Color fundus photograph — 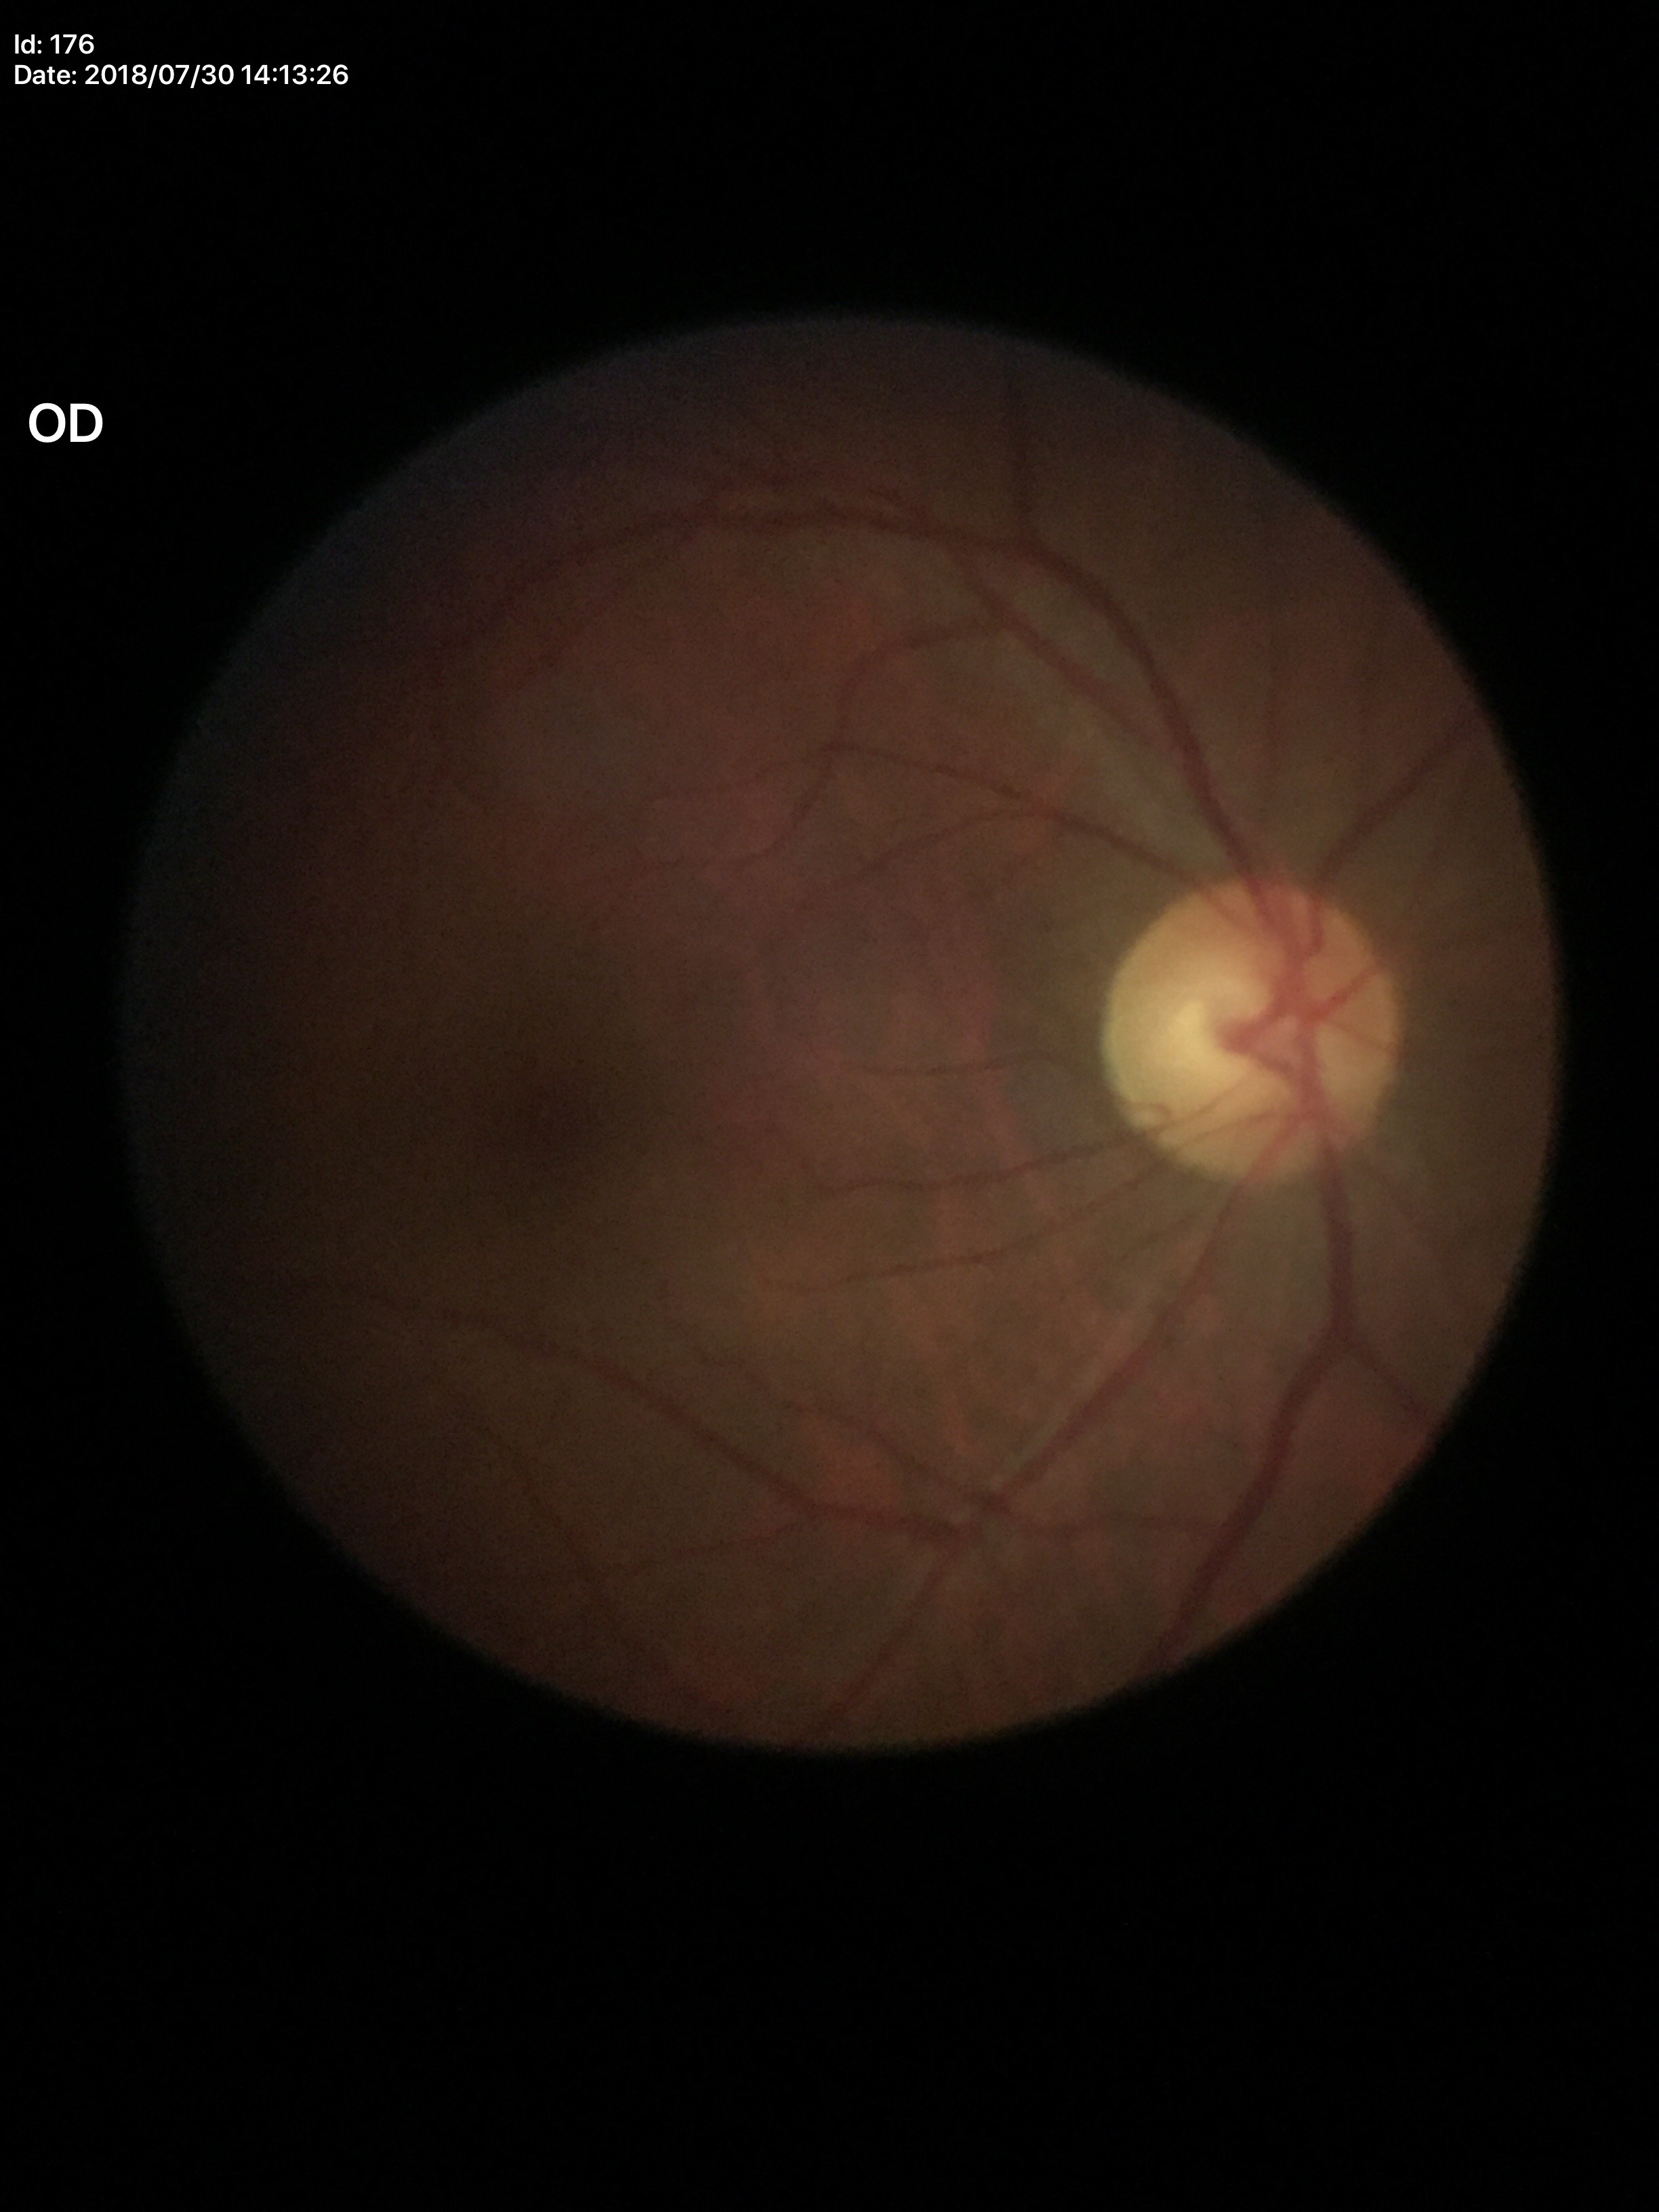 Vertical cup-disc ratio (VCDR): 0.58.
Not suspicious for glaucoma.